2048x1536px; 45° FOV.
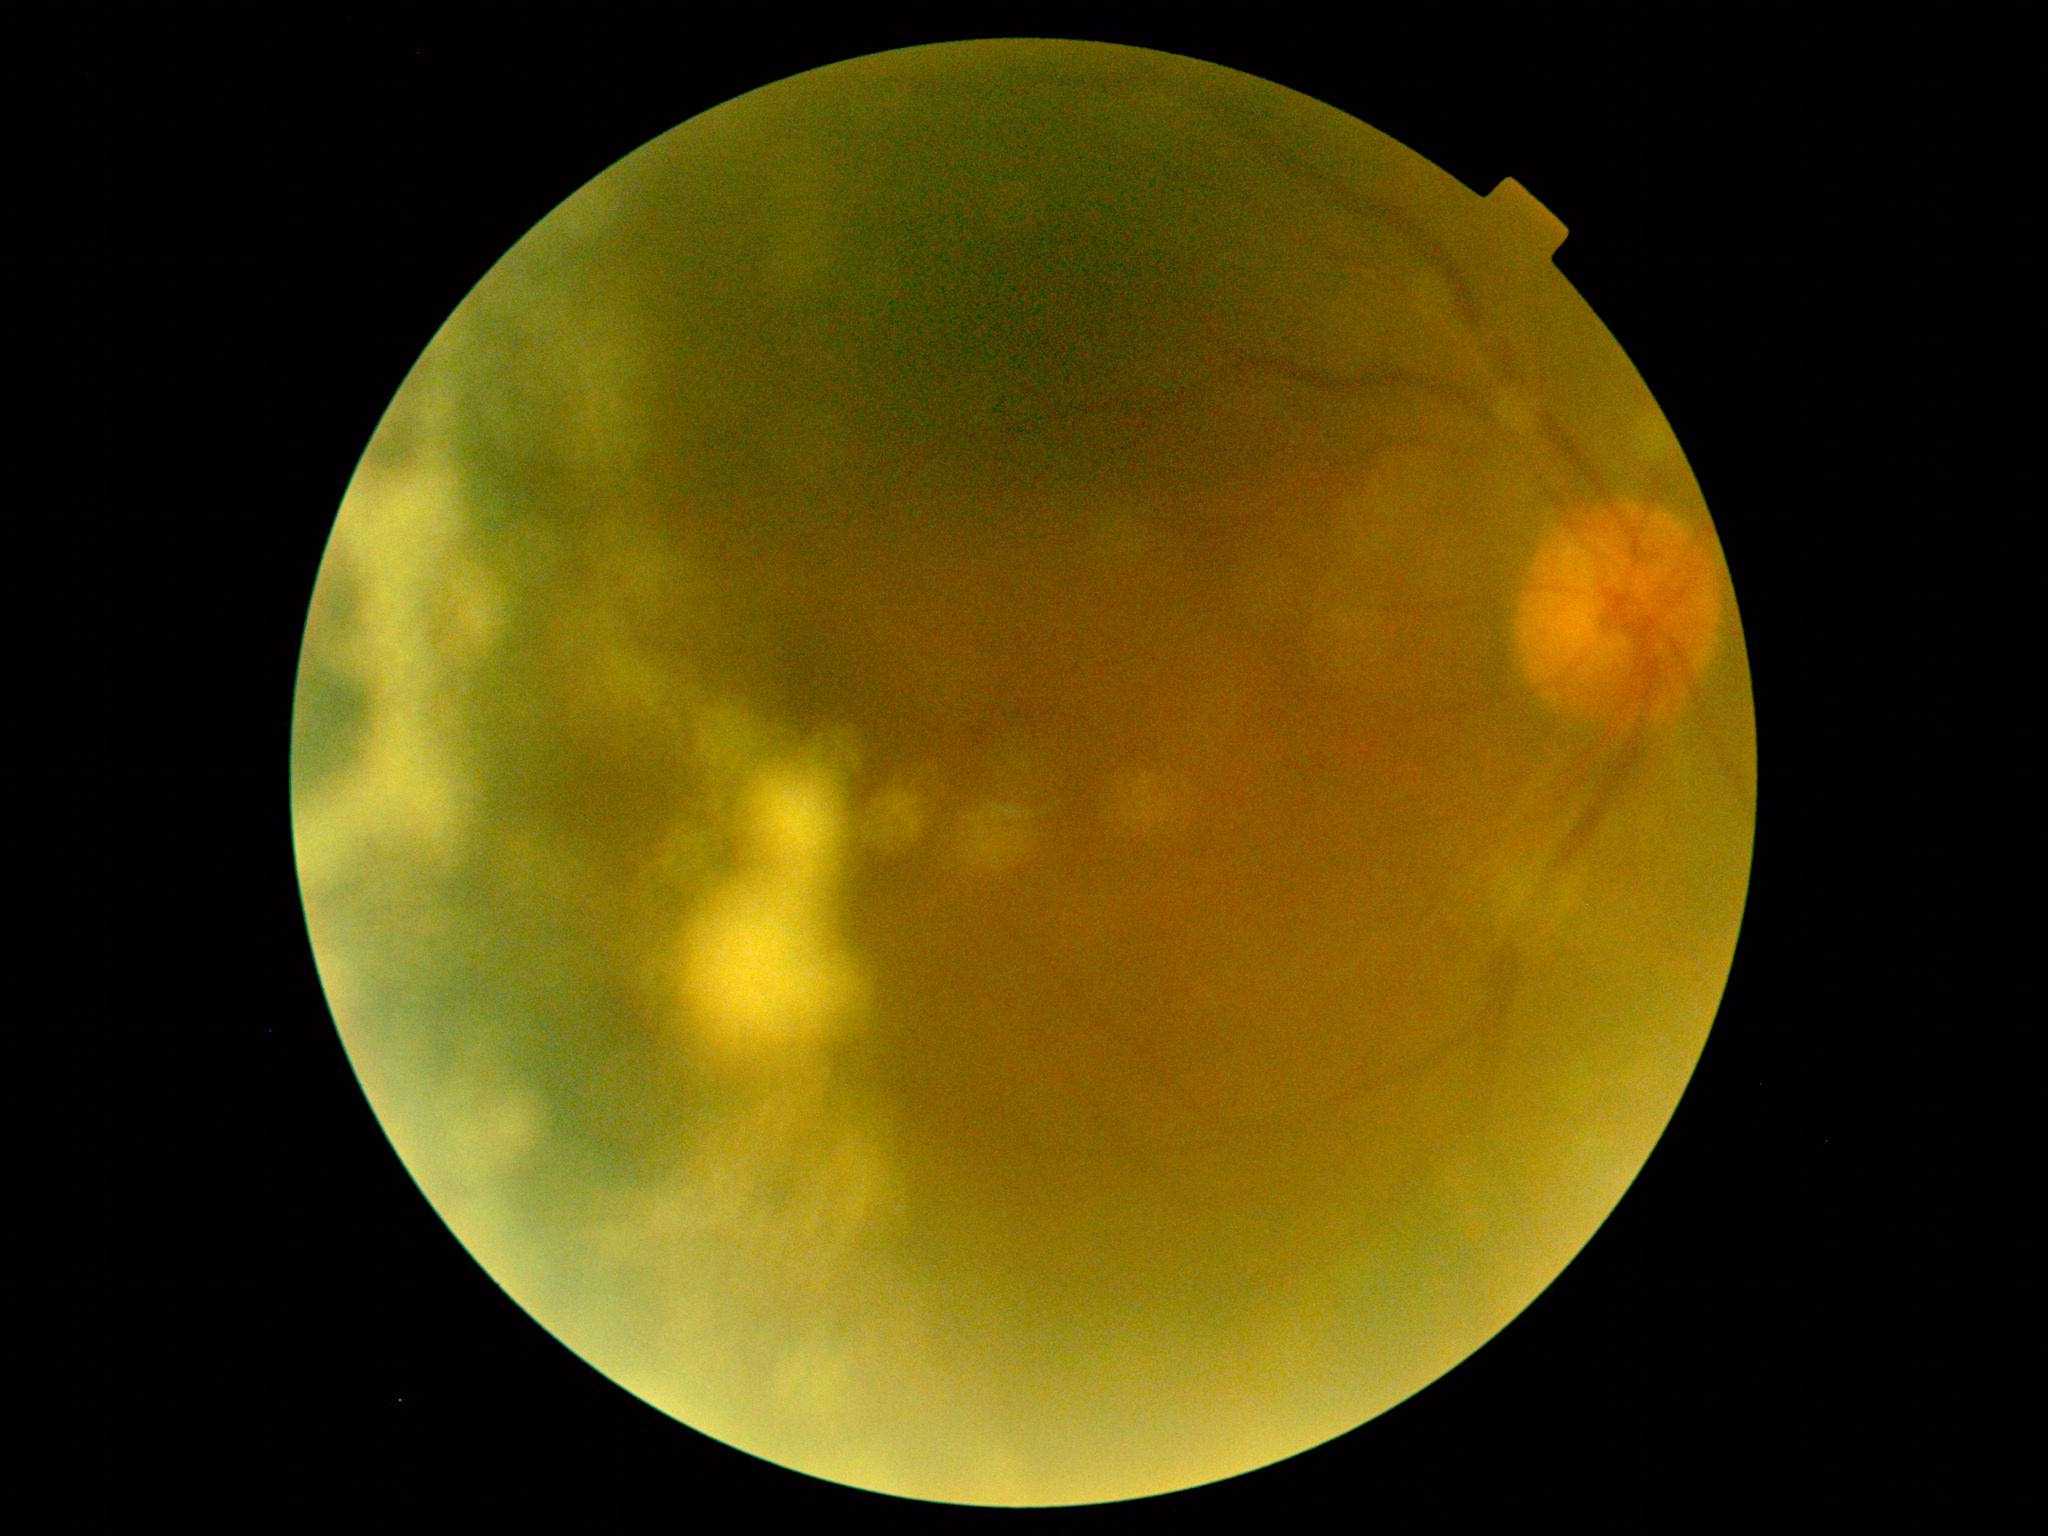

image quality = too poor for DR grading | DR severity = ungradable due to poor image quality.